Image size 2212x1659. FOV: 45 degrees — 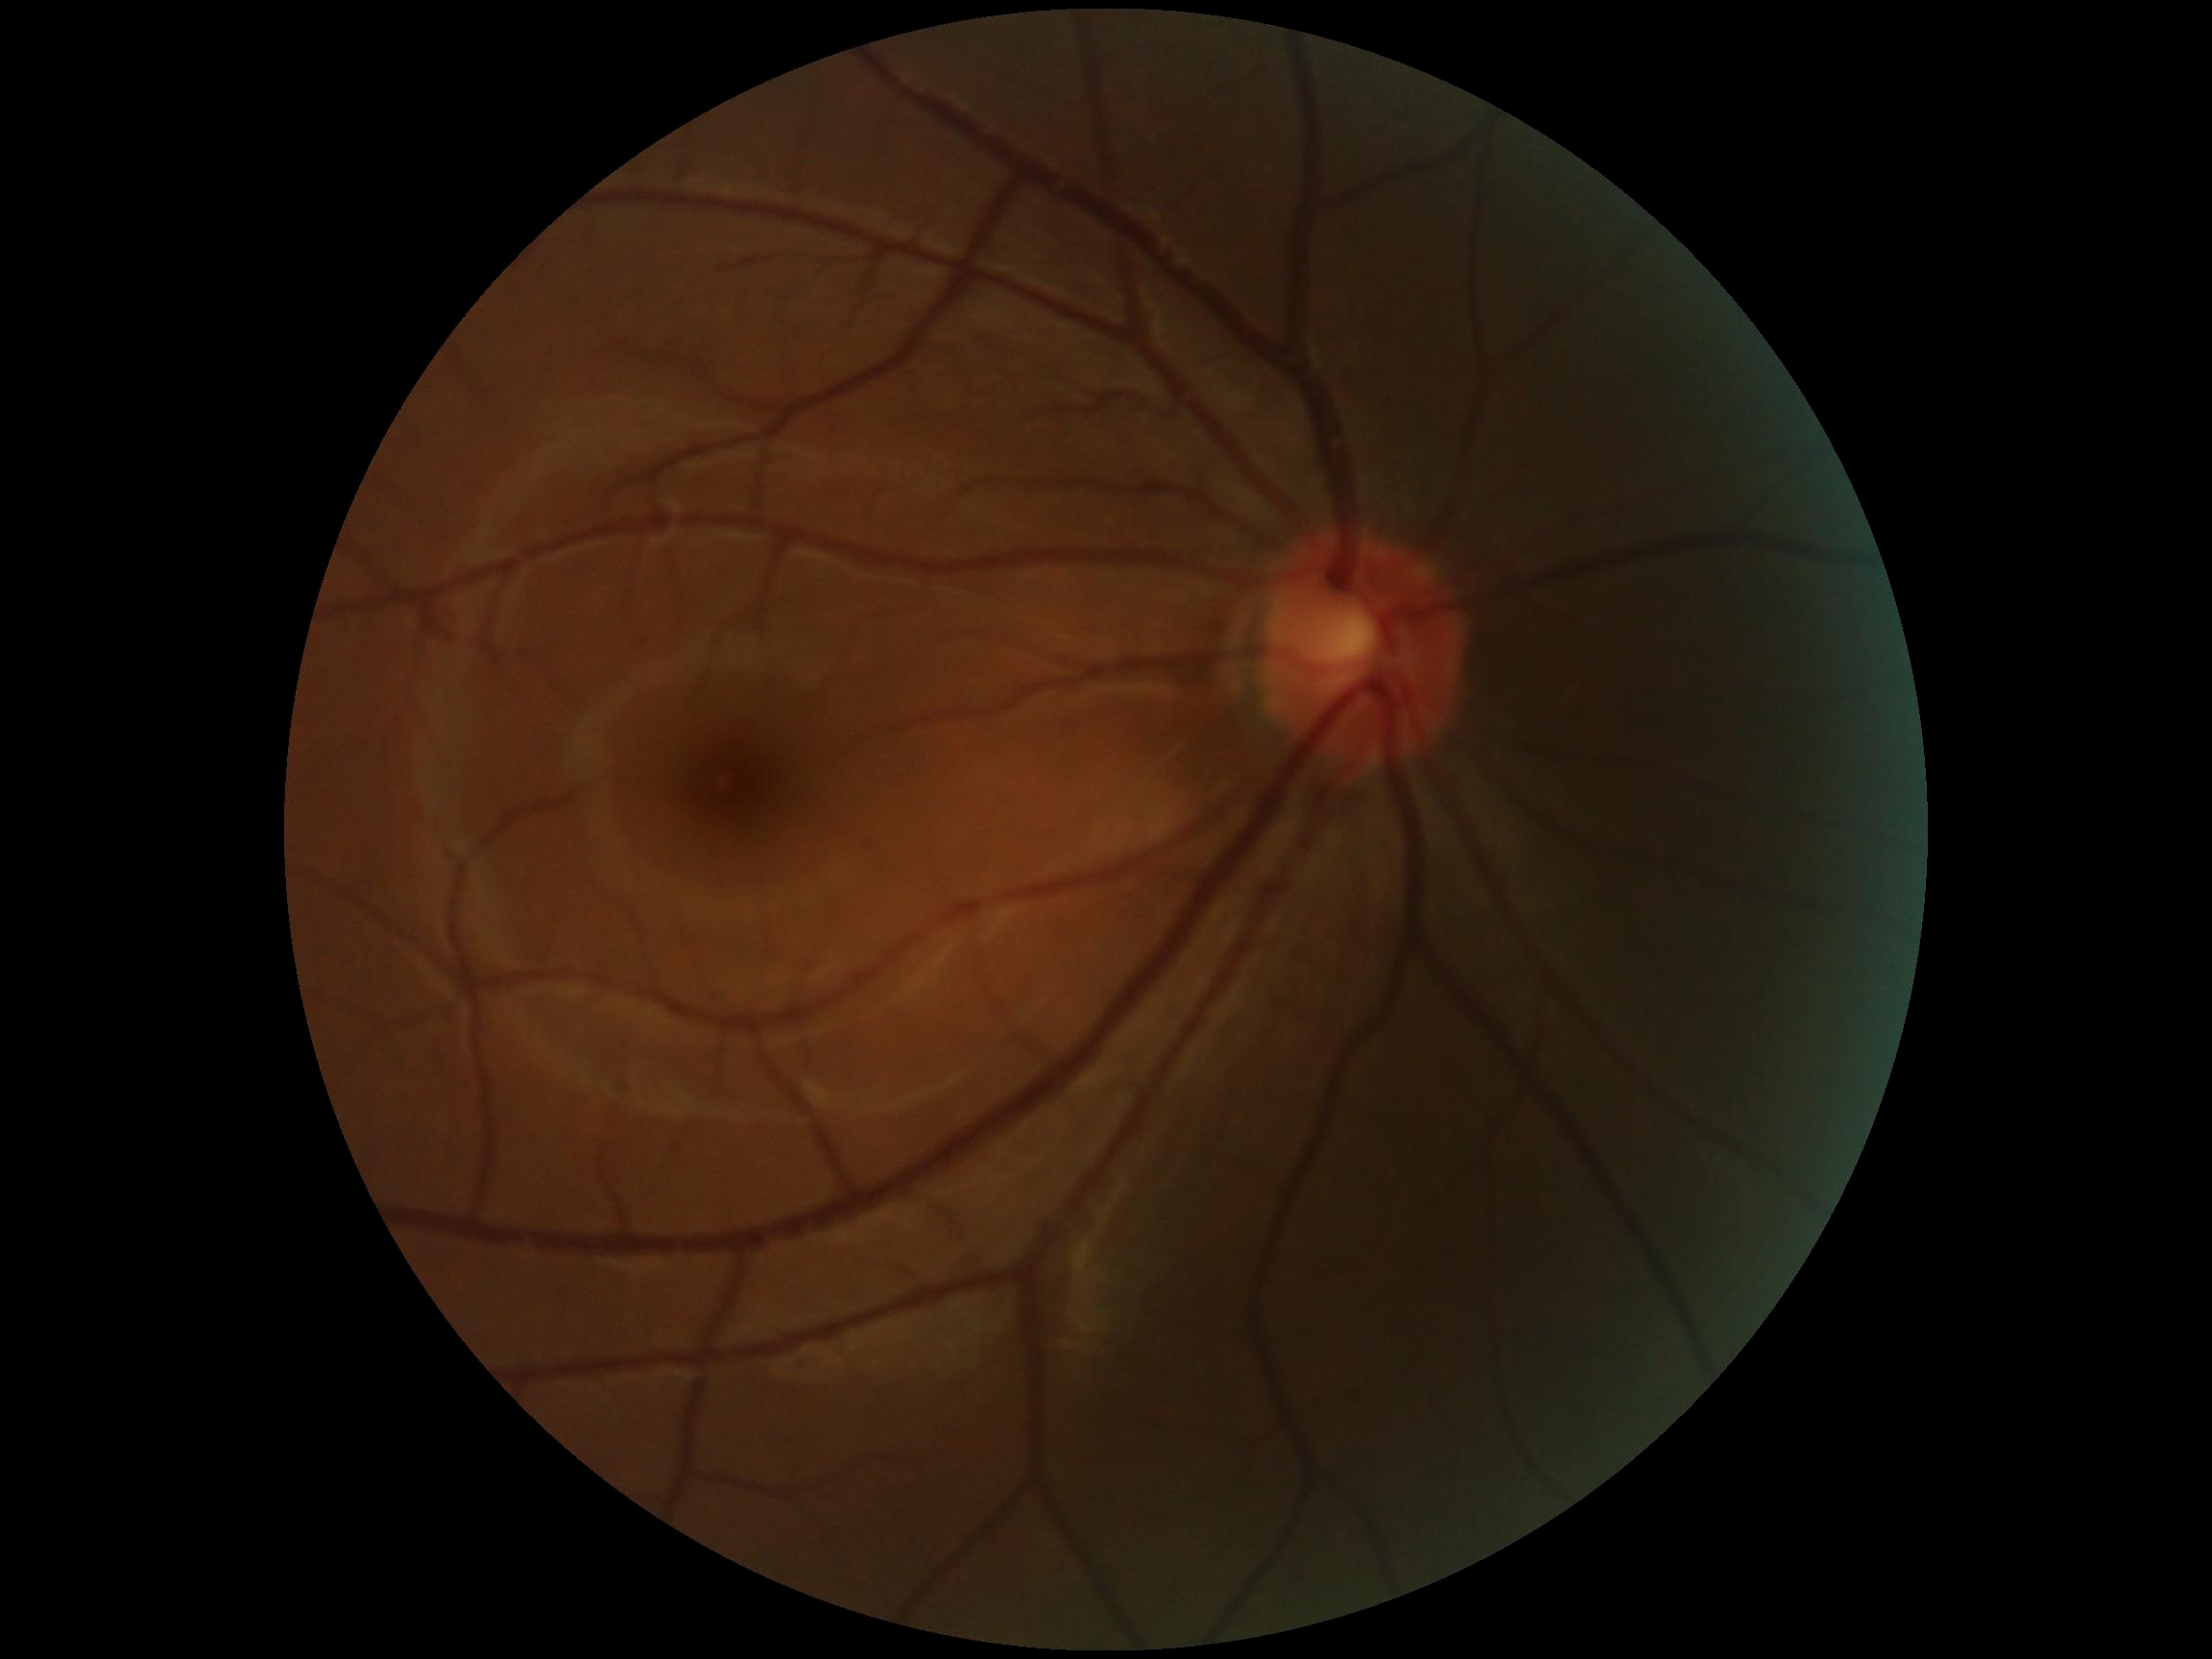 Diabetic retinopathy severity is no apparent diabetic retinopathy (grade 0).